45° FOV. 2212 x 1672 pixels.
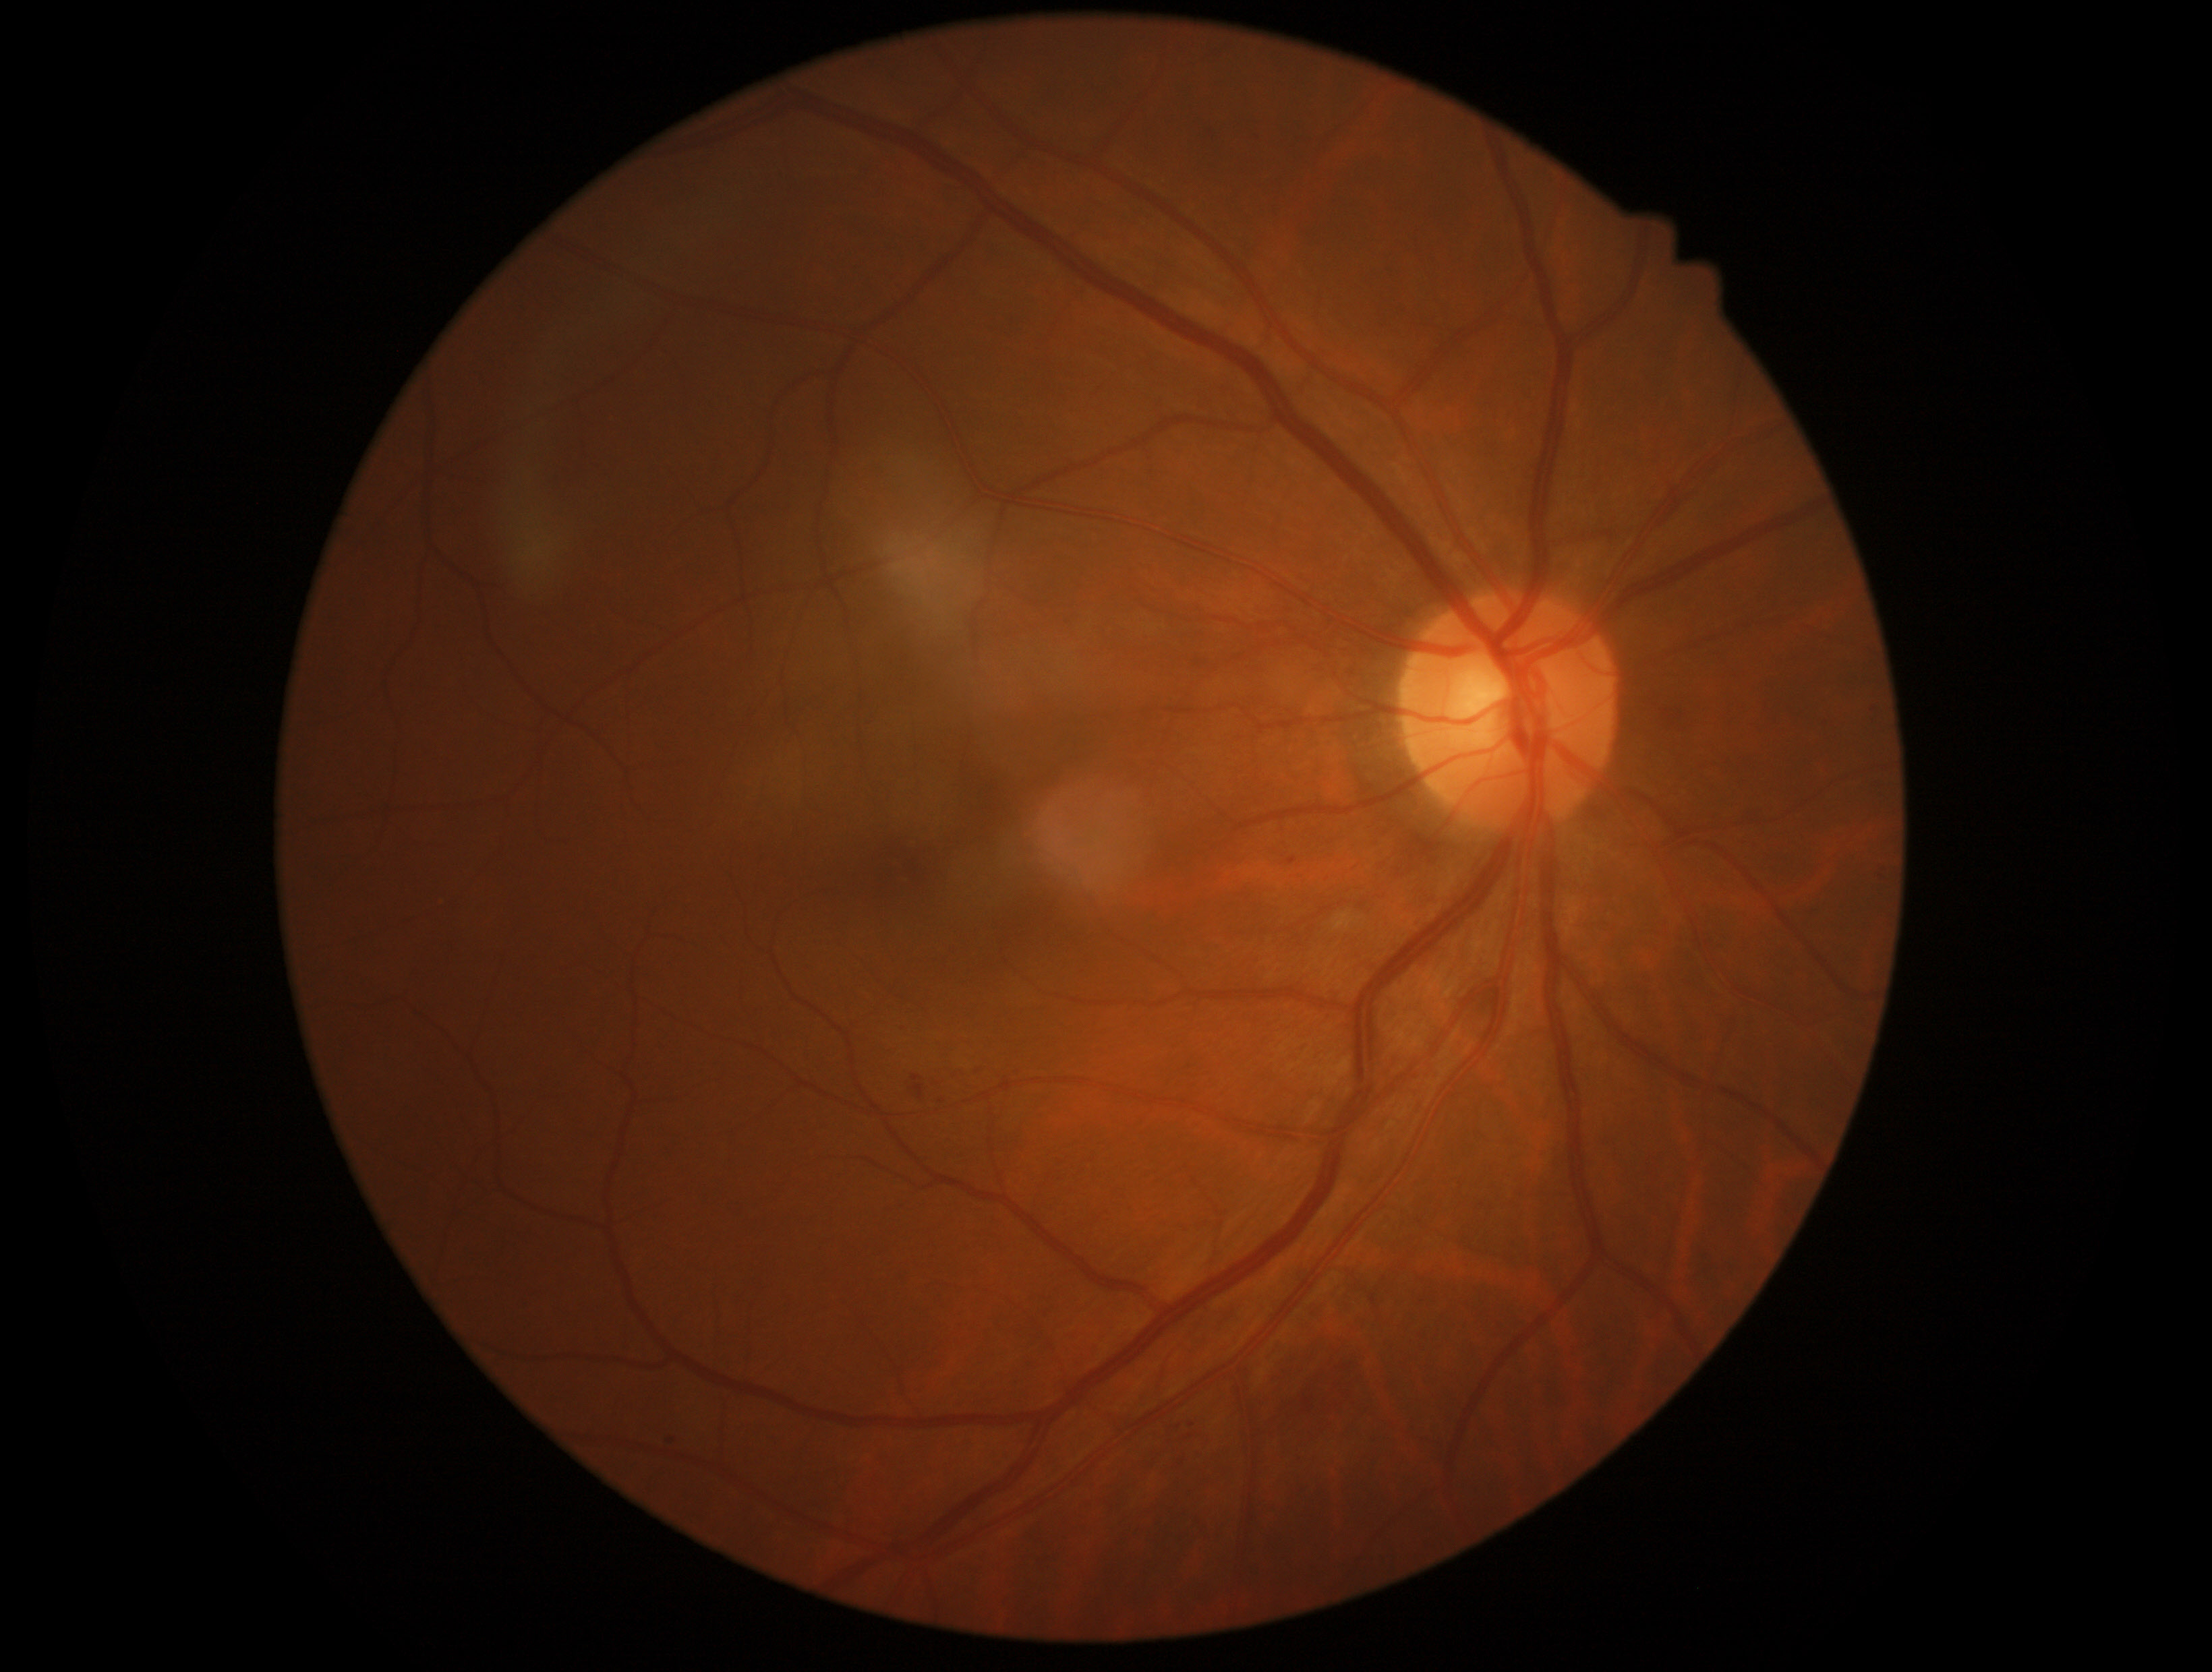

Disease class: non-proliferative diabetic retinopathy. Diabetic retinopathy: grade 2 (moderate NPDR).